Acquired with a NIDEK AFC-230: 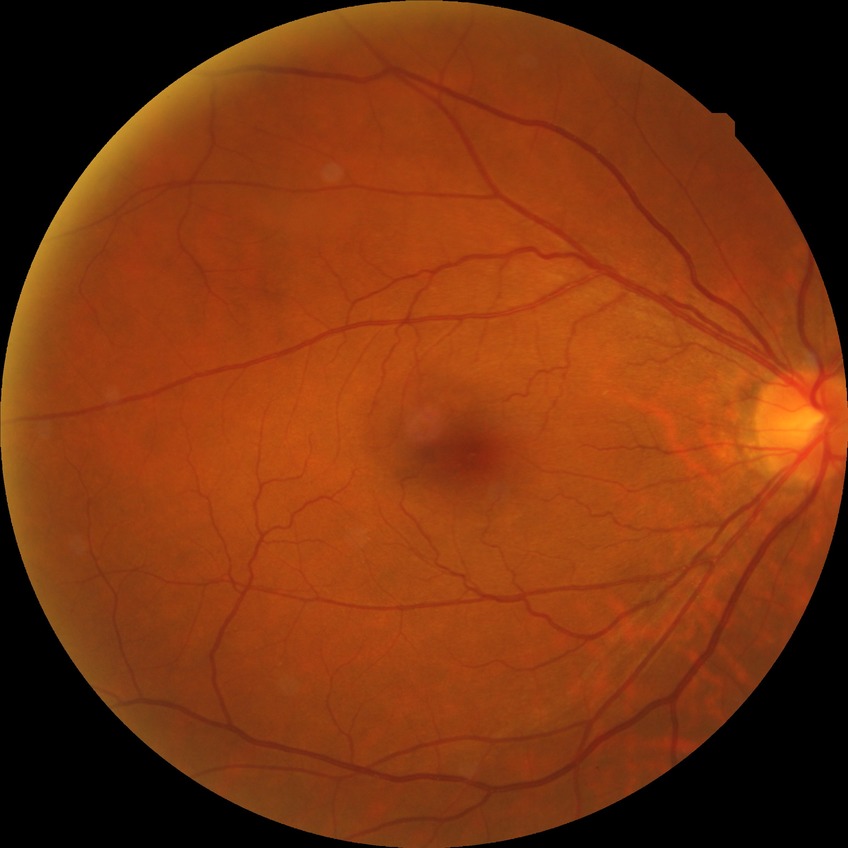
Diabetic retinopathy (DR) is NDR (no diabetic retinopathy).